Wide-field fundus photograph of an infant; 1440 by 1080 pixels — 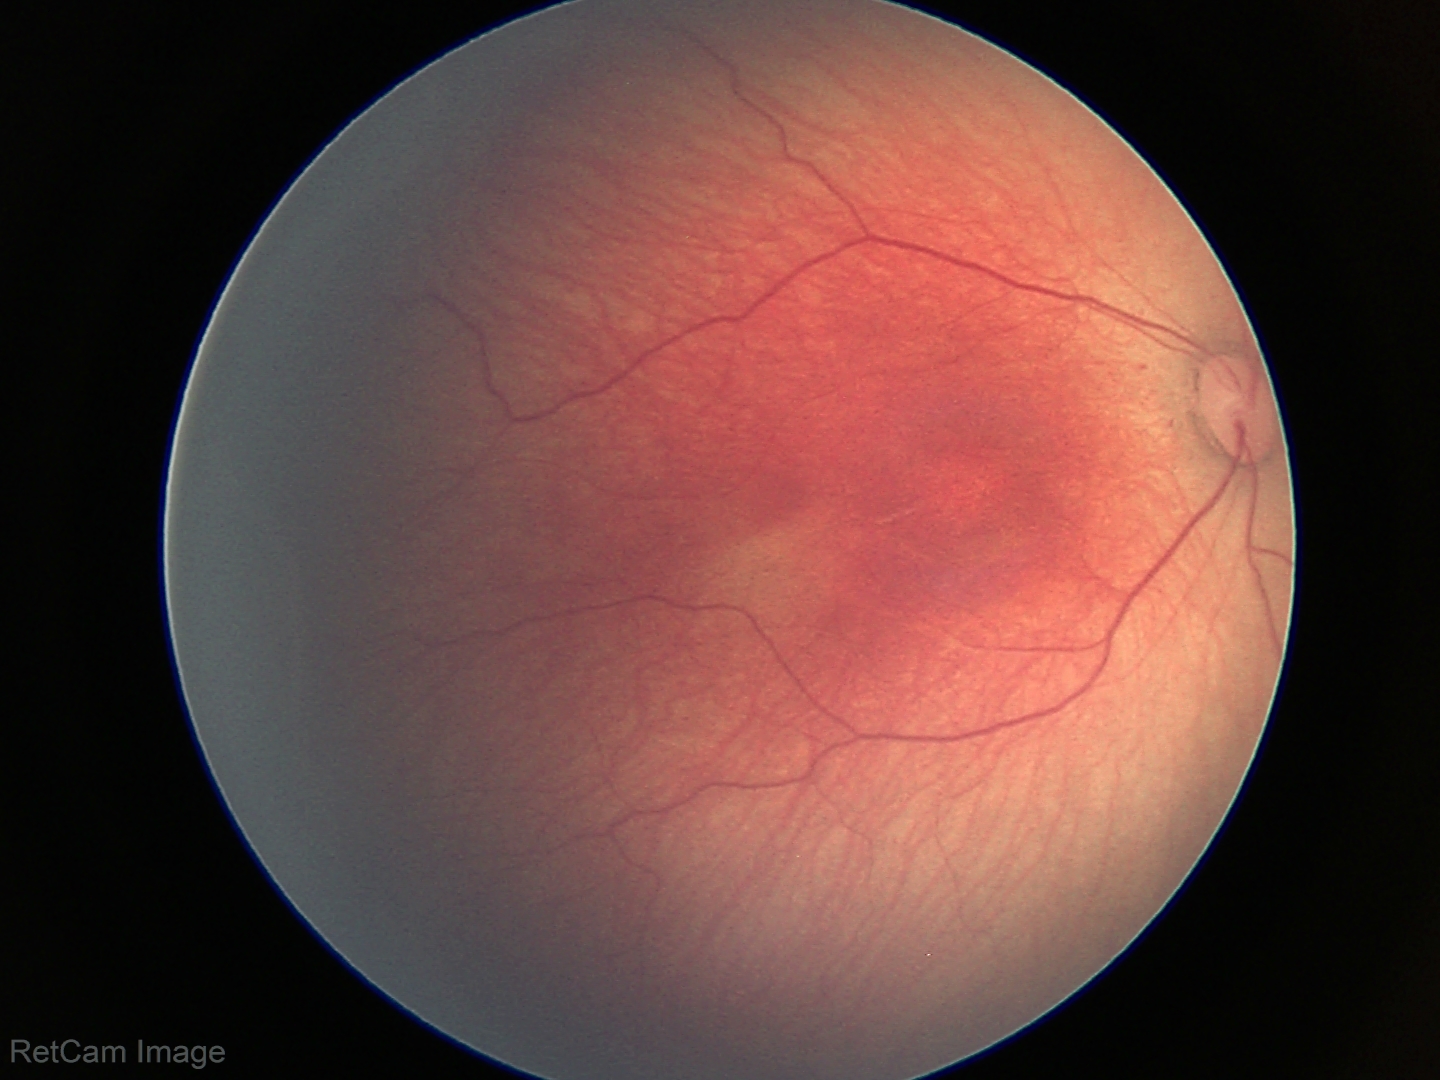

Assessment: ROP stage 2 — ridge with height and width at the demarcation line.